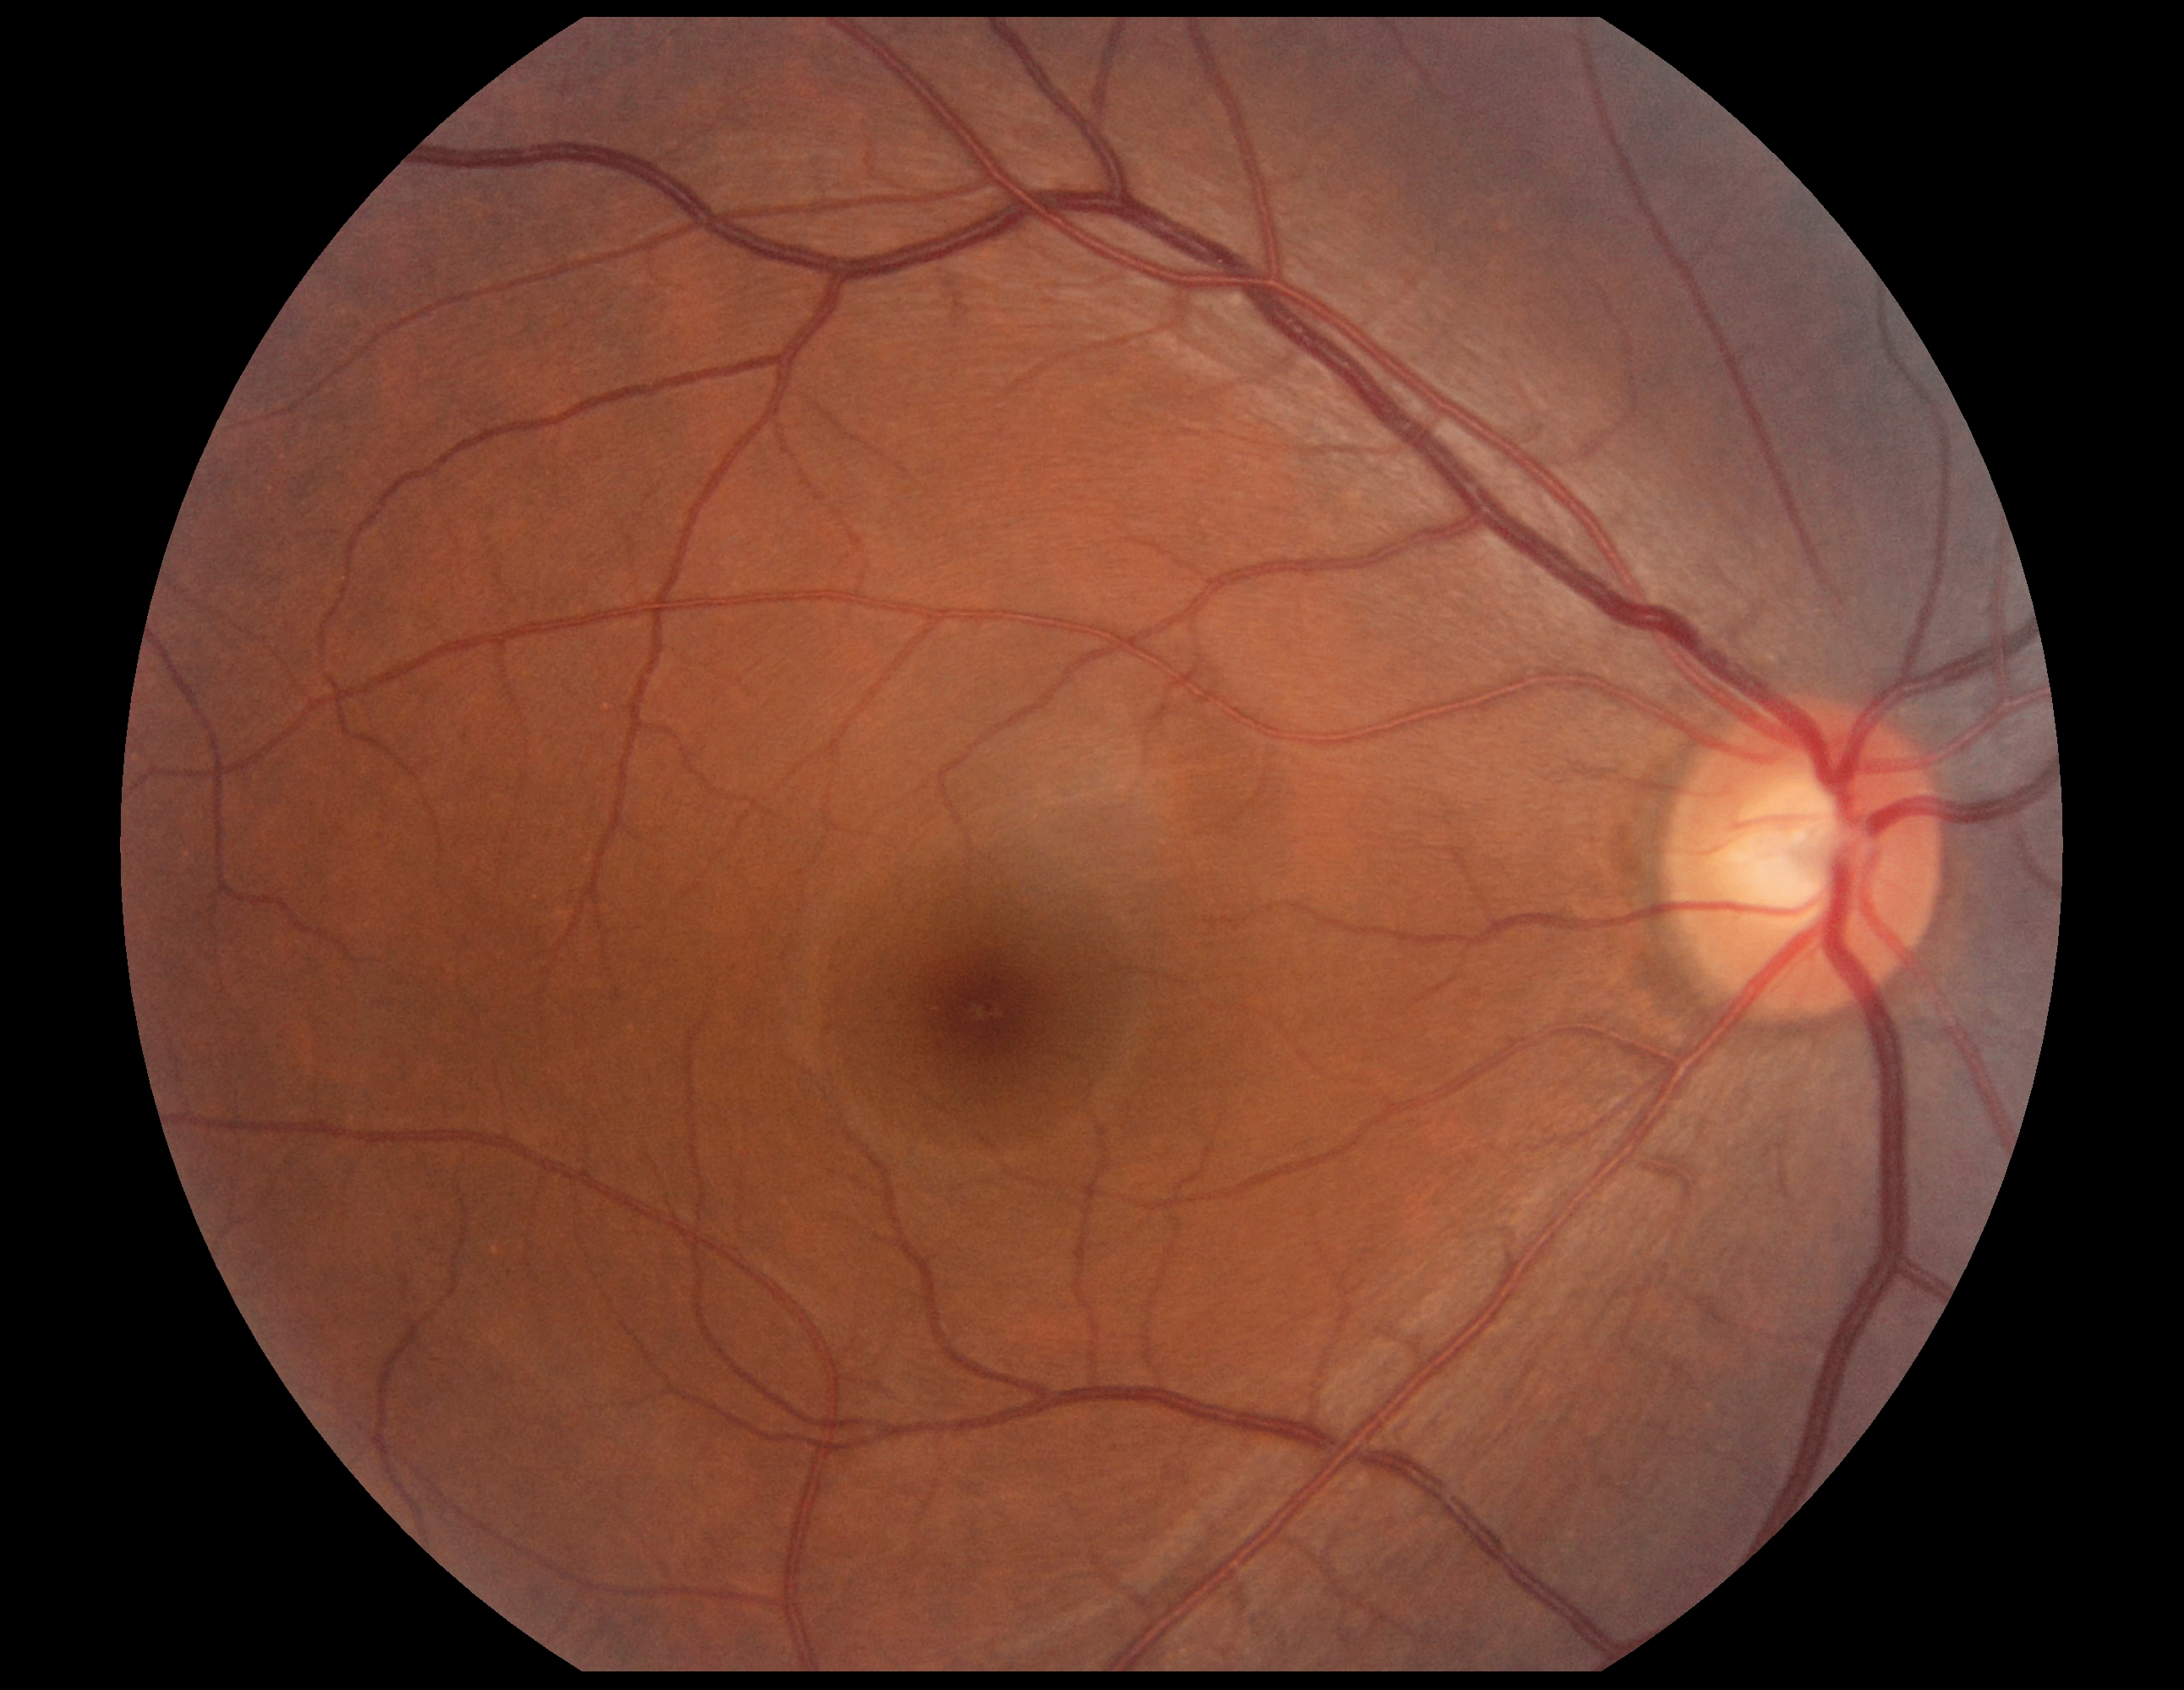
Annotations:
* diabetic retinopathy grade — 0